Davis DR grading · posterior pole color fundus photograph.
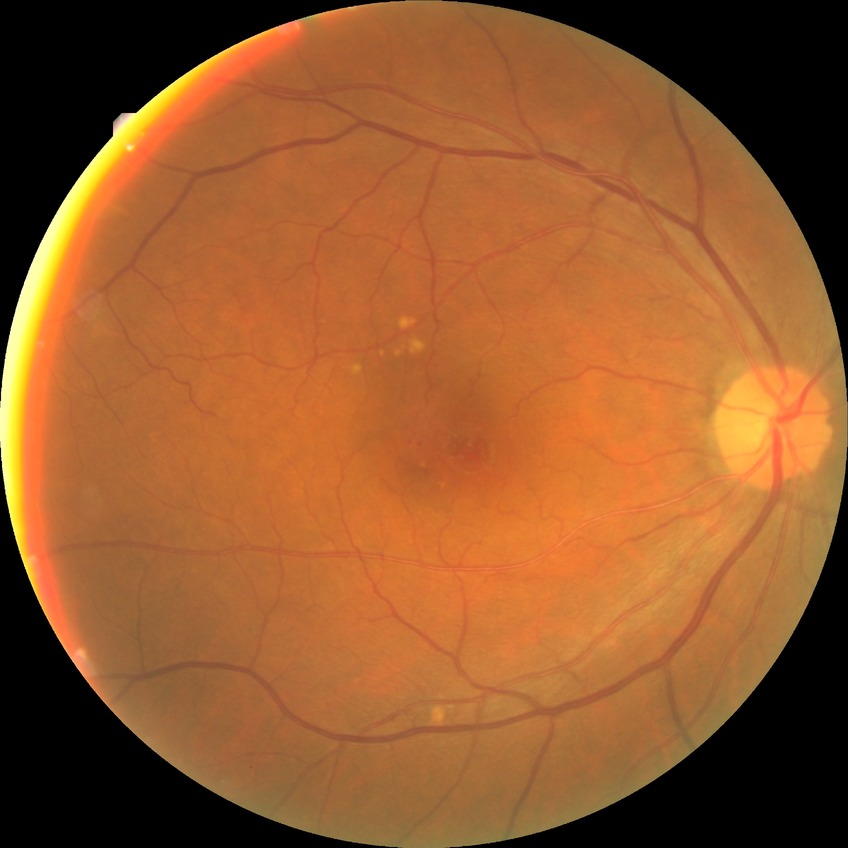
Disease class: non-proliferative diabetic retinopathy. Diabetic retinopathy (DR): simple diabetic retinopathy (SDR).